848x848px. Camera: NIDEK AFC-230:
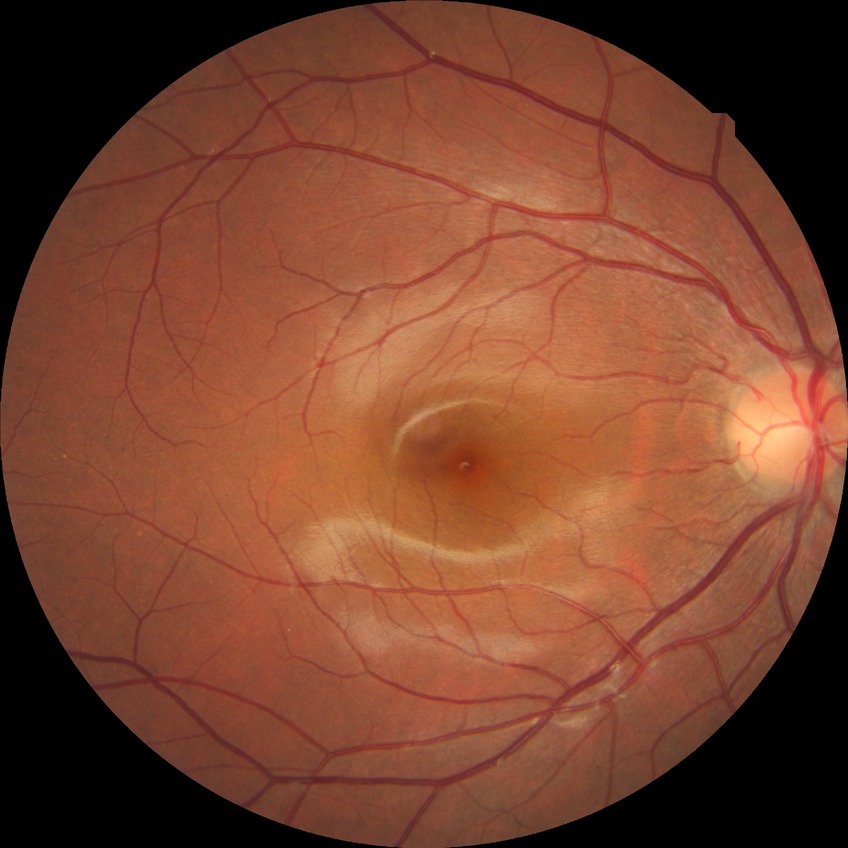
DR severity: NDR.